Color fundus photograph.
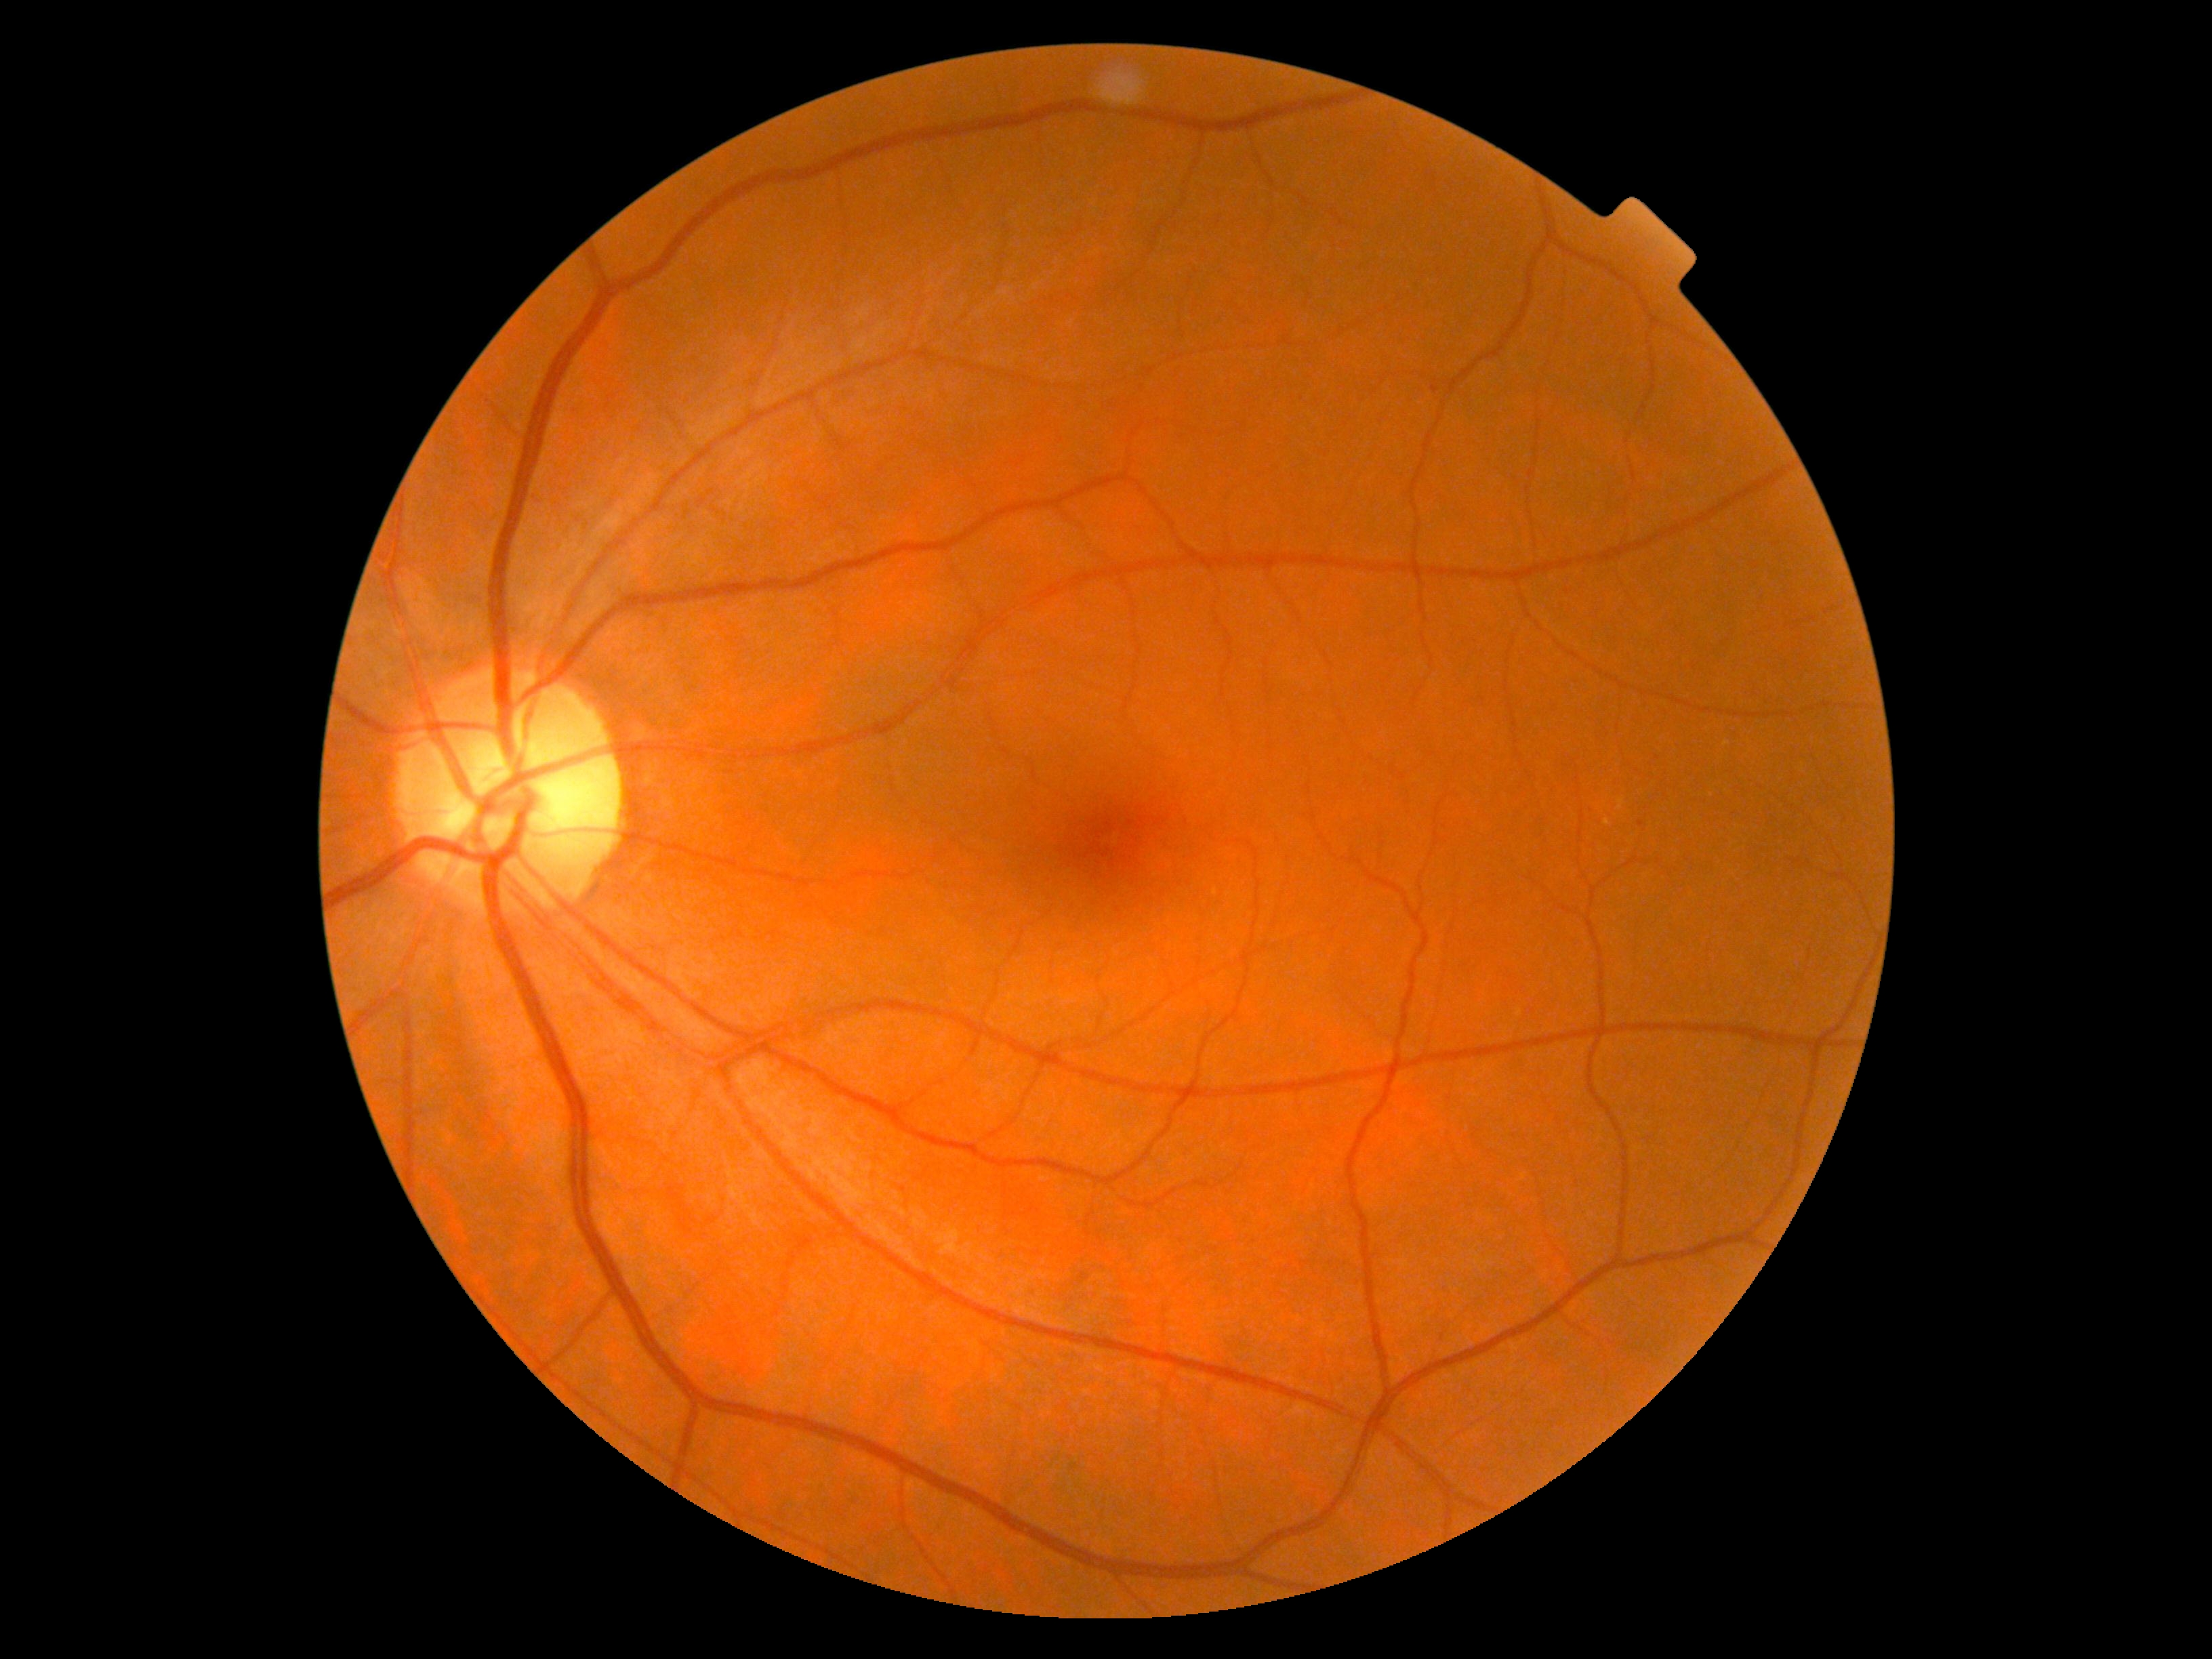 No DR findings. Diabetic retinopathy (DR): grade 0.